Color fundus image: 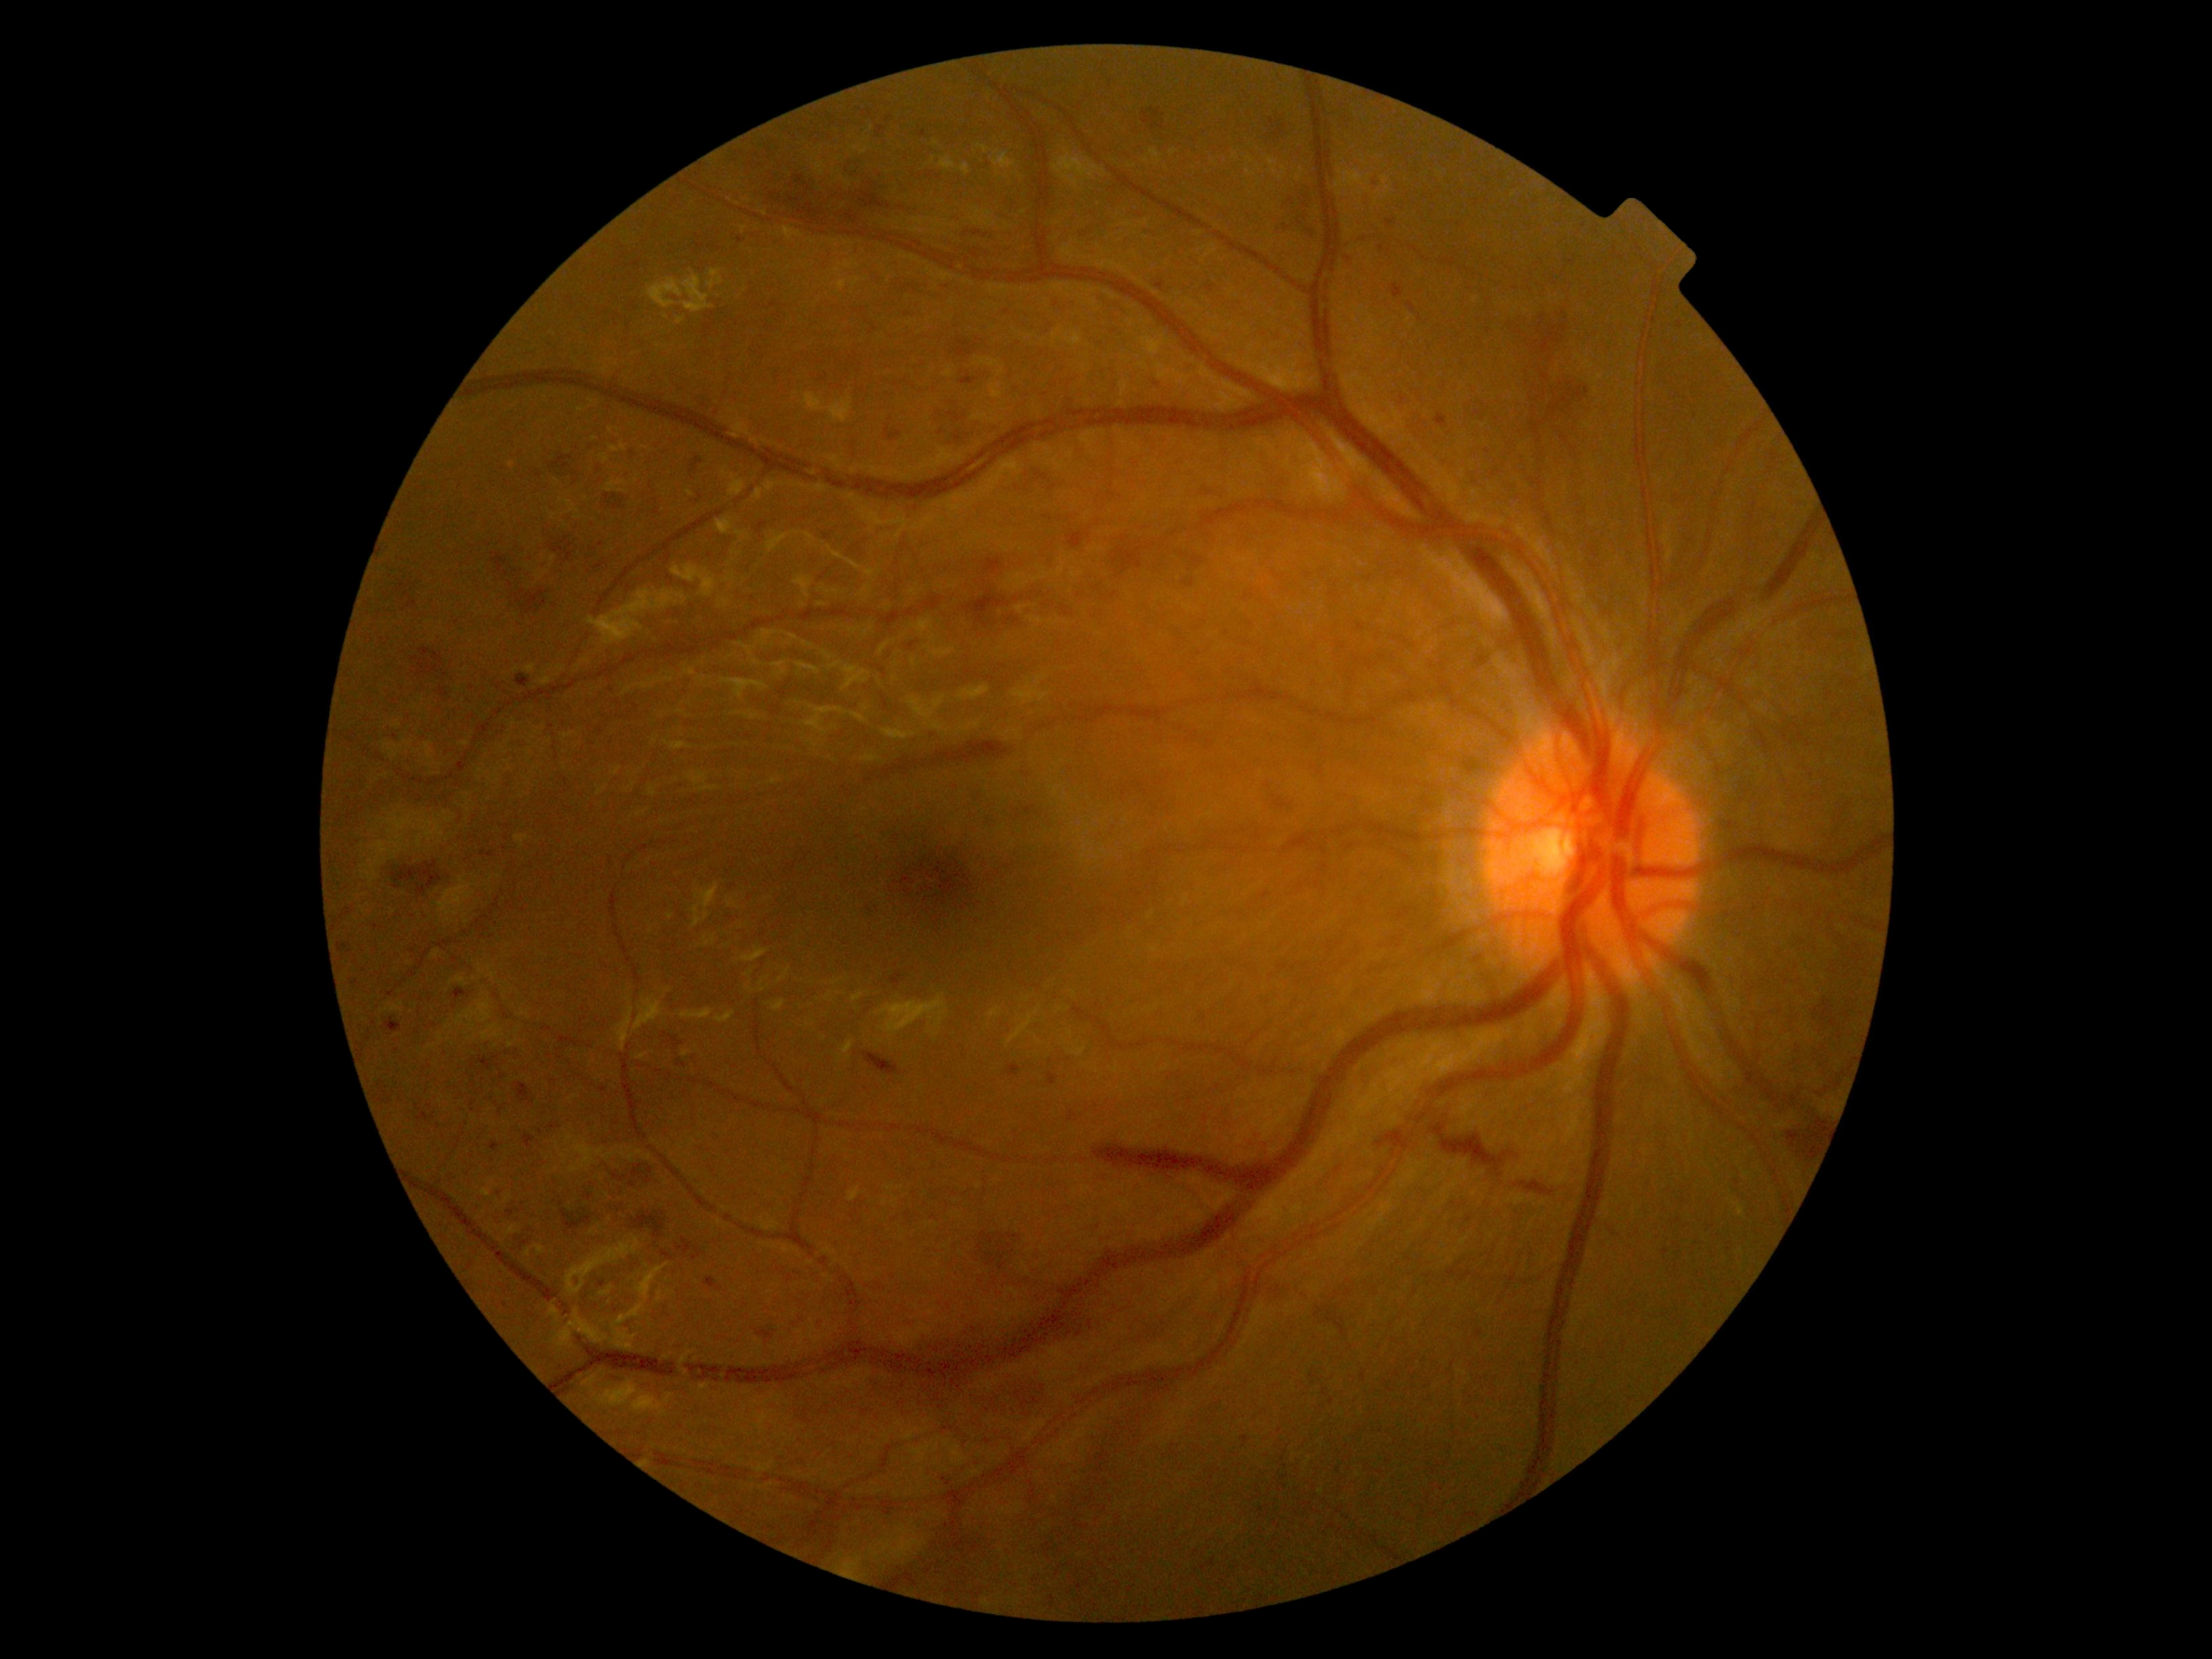
<lesions partial="true">
  <dr_grade>3</dr_grade>
  <ex />
  <se />
  <he partial="true">Rect(476, 1204, 489, 1214); Rect(982, 558, 1004, 574); Rect(886, 426, 902, 441); Rect(583, 1193, 593, 1200); Rect(516, 674, 529, 688); Rect(453, 989, 470, 1000); Rect(391, 861, 443, 888); Rect(1677, 321, 1683, 329); Rect(909, 1307, 1104, 1386); Rect(861, 110, 874, 119); Rect(597, 489, 630, 514); Rect(972, 230, 989, 238); Rect(493, 552, 555, 617); Rect(491, 1057, 499, 1061); Rect(952, 337, 977, 357)</he>
  <he_small_approx>pt(656, 500); pt(1419, 319); pt(593, 550); pt(1028, 774); pt(390, 1101)</he_small_approx>
  <ma />
</lesions>